Captured without pupil dilation · optic nerve head crop.
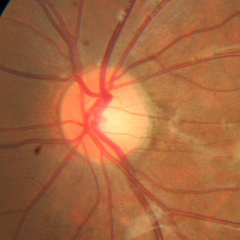

Showing no glaucomatous changes.